Wide-field contact fundus photograph of an infant. Image size 1440x1080: 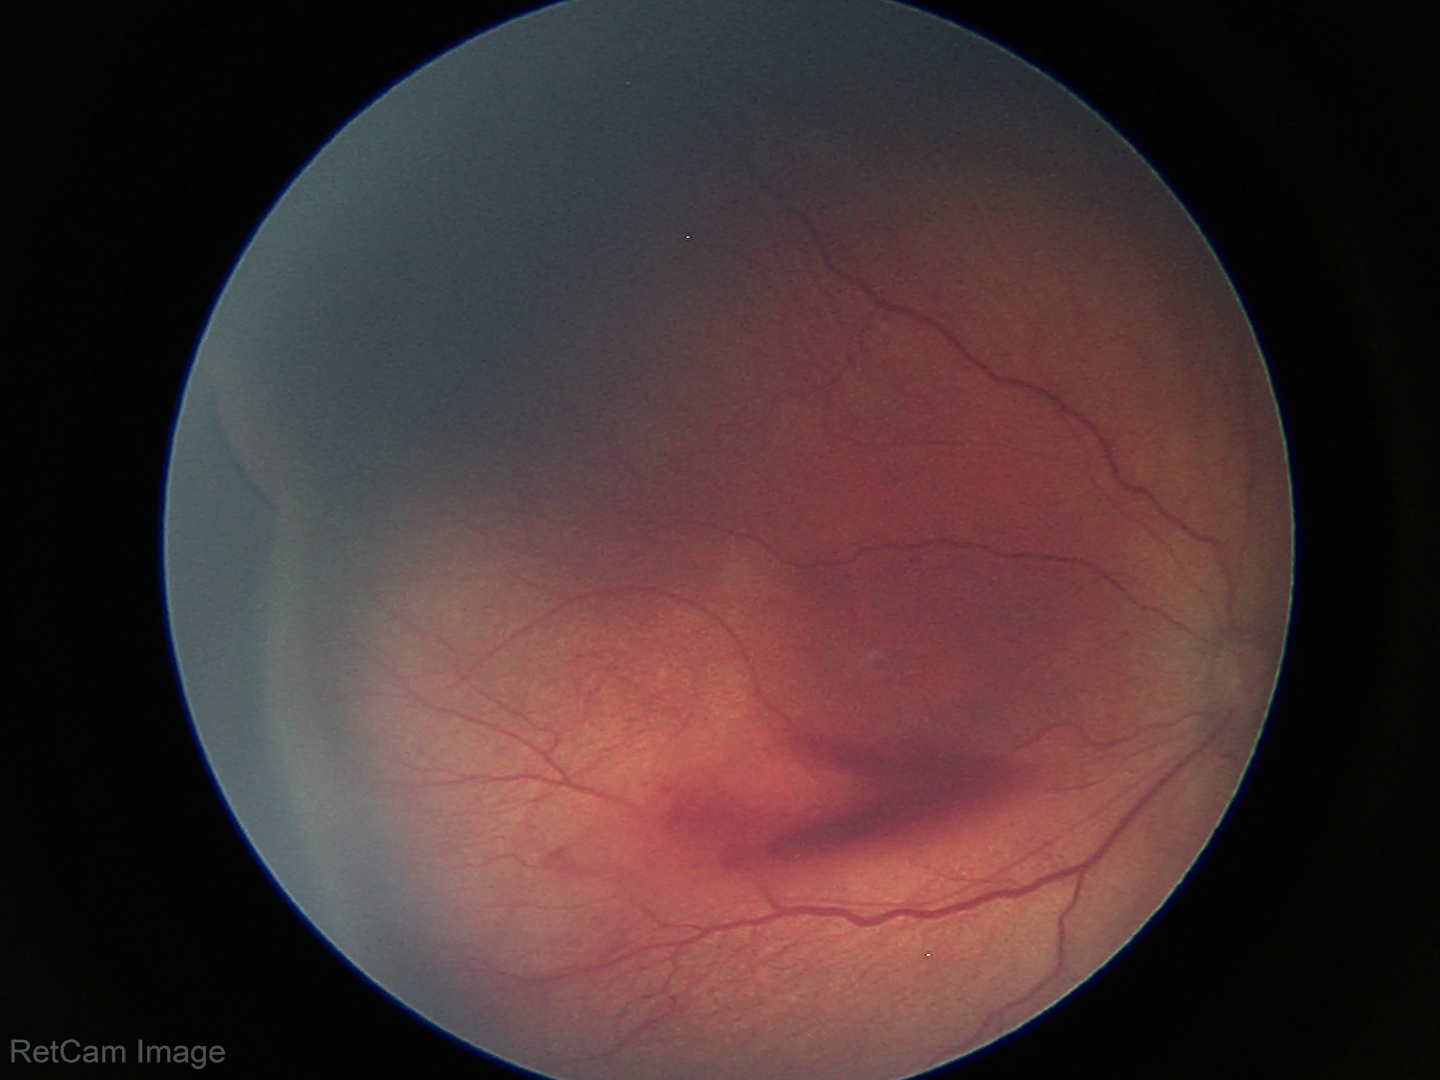

Assessment = retinopathy of prematurity stage 3
plus disease = absent